Captured after pupil dilation, CFP
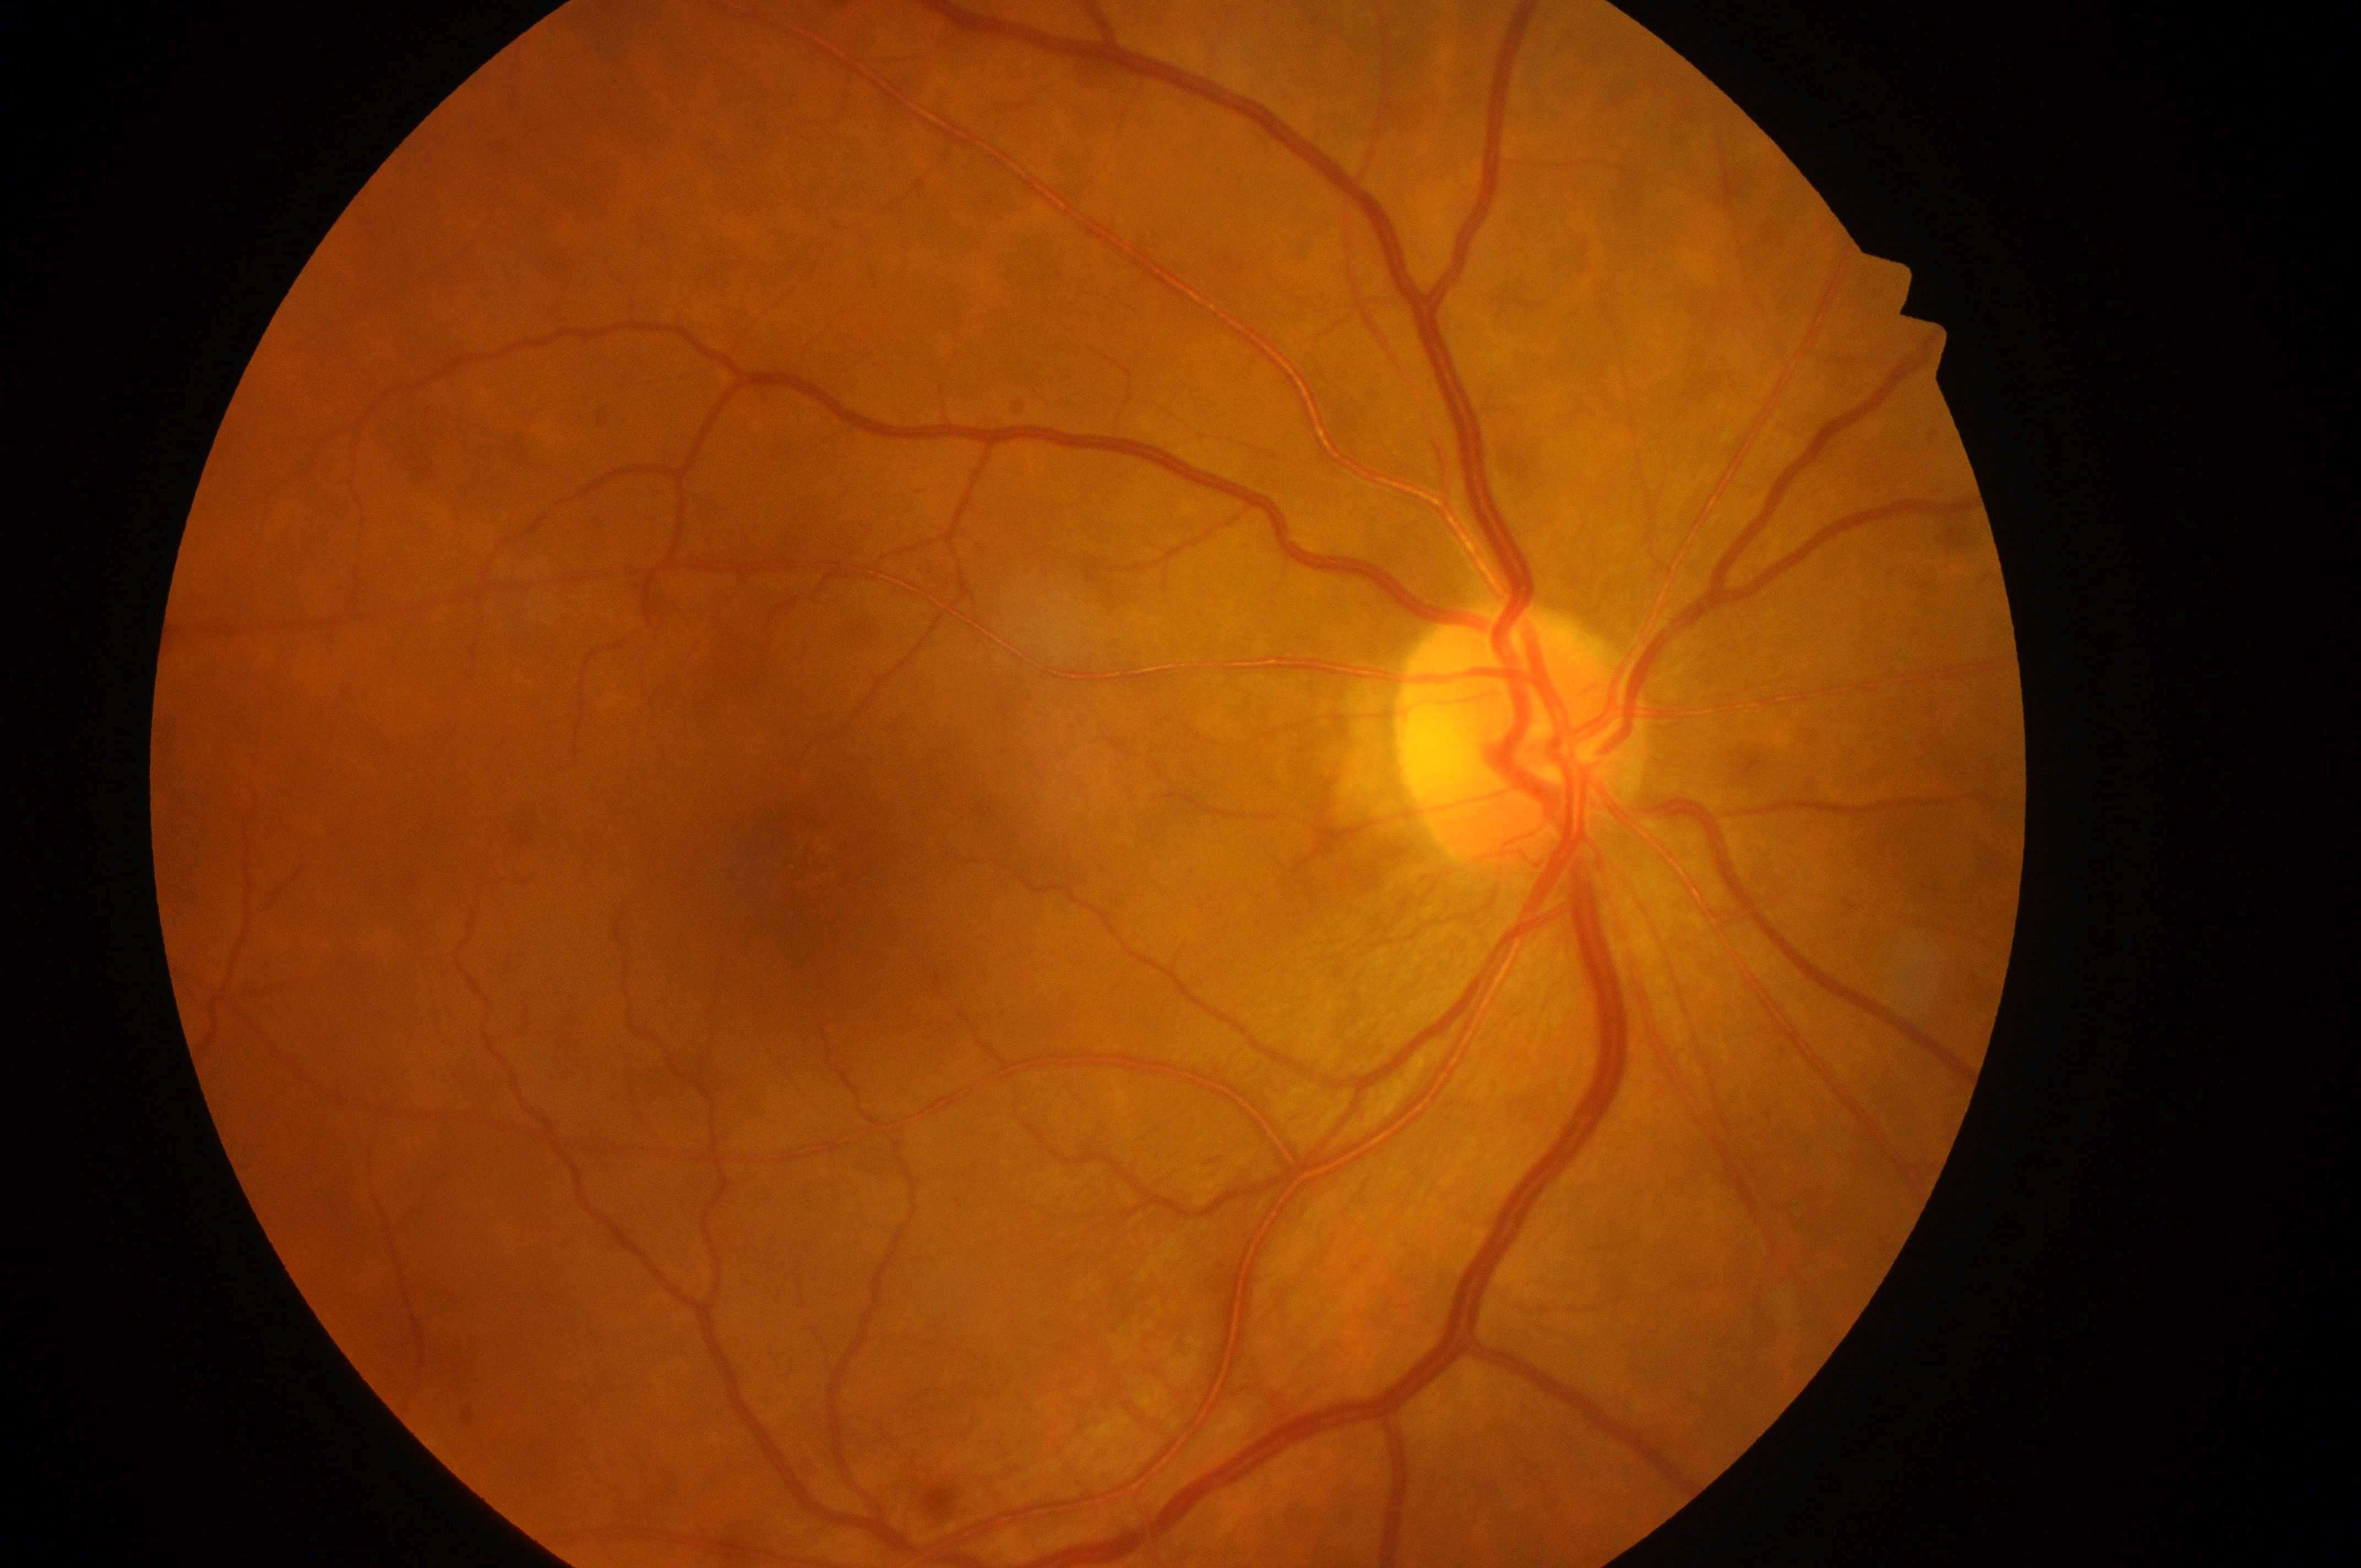 Diabetic retinopathy (DR) is grade 0 (no apparent retinopathy) — no visible signs of diabetic retinopathy.
The macular center is at x=817, y=868.
The image shows the right eye.
No DR or DME findings.
Diabetic macular edema (DME) is grade 0 (no risk) — no apparent hard exudates.
Optic disk located at x=1512, y=742.